Posterior pole color fundus photograph
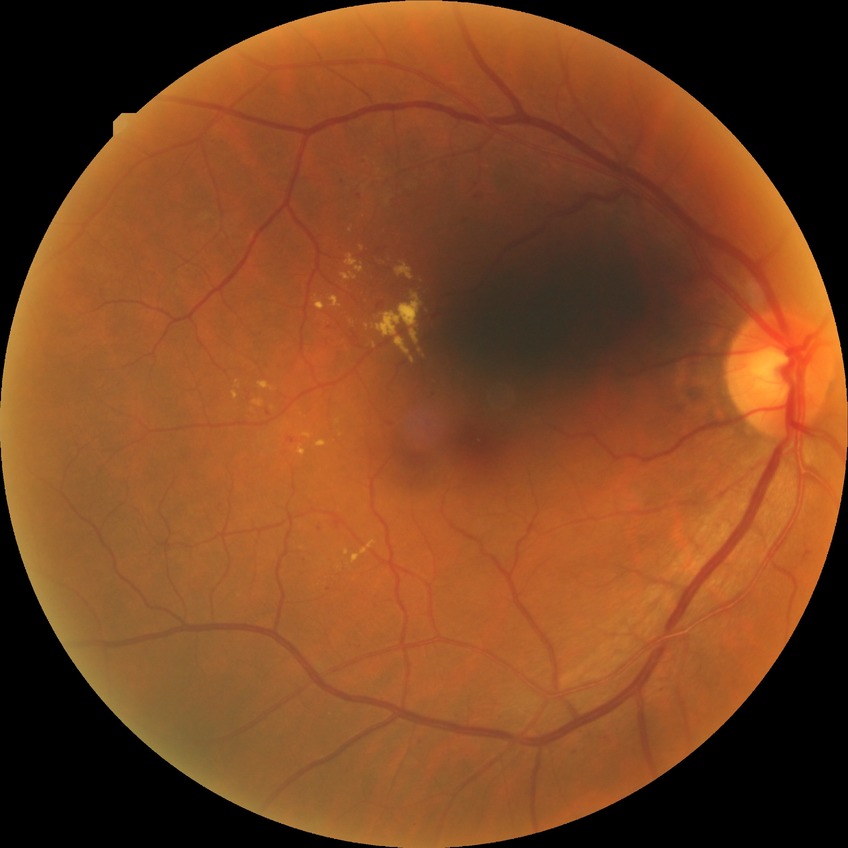 Diabetic retinopathy (DR): SDR (simple diabetic retinopathy). Disease class: non-proliferative diabetic retinopathy.